Nonmydriatic, 848x848px, retinal fundus photograph, FOV: 45 degrees, acquired with a NIDEK AFC-230
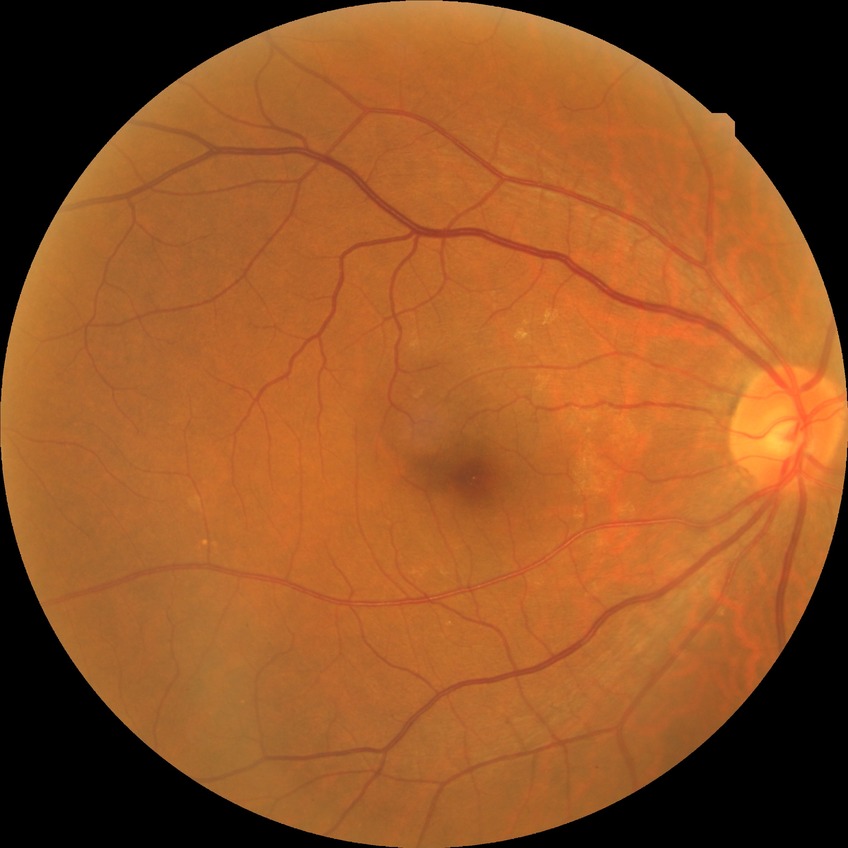 Diabetic retinopathy (DR) is no diabetic retinopathy (NDR).